Fundus photo; 45-degree field of view
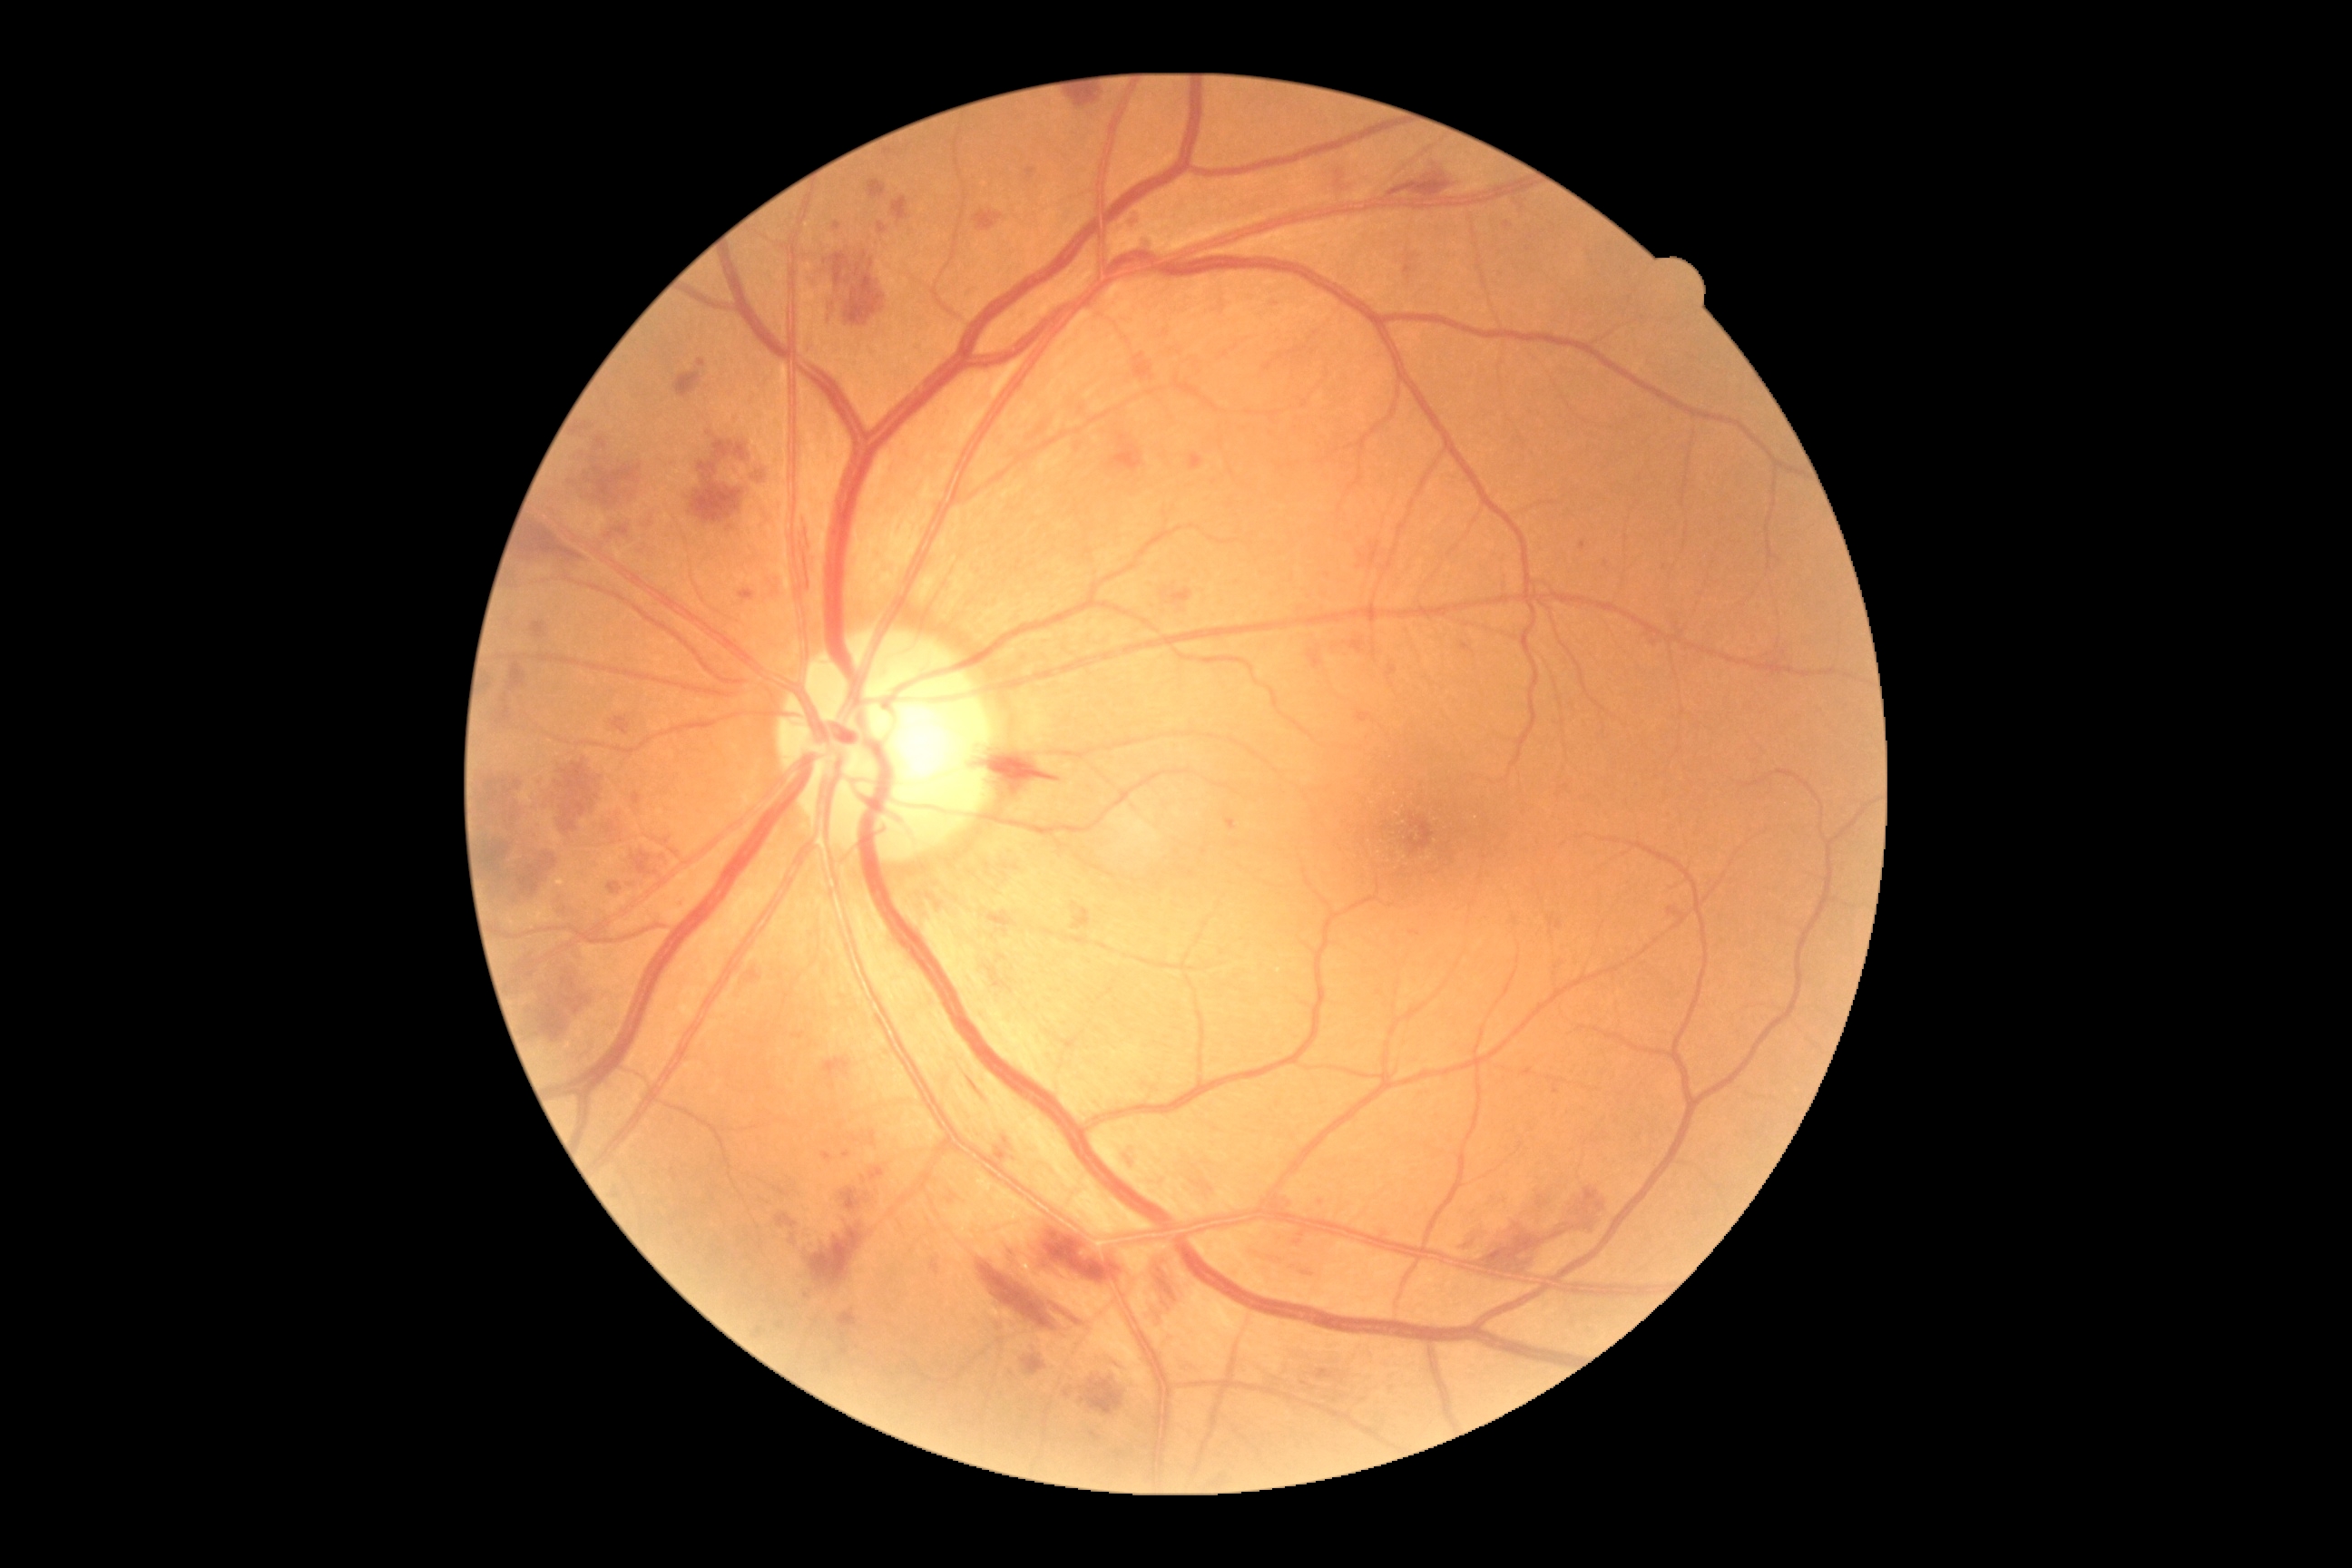 partial: true
dr_grade: 3
lesions:
  ma:
    - bbox(794, 1034, 803, 1041)
    - bbox(1293, 1240, 1302, 1246)
    - bbox(596, 436, 607, 449)
    - bbox(738, 589, 754, 602)
    - bbox(968, 291, 975, 300)
    - bbox(1112, 1364, 1124, 1371)
    - bbox(632, 792, 642, 805)
    - bbox(1547, 917, 1554, 928)
    - bbox(531, 622, 545, 640)
    - bbox(930, 1257, 939, 1275)
    - bbox(1411, 932, 1420, 936)
    - bbox(1115, 1451, 1124, 1460)
    - bbox(1580, 542, 1587, 551)
    - bbox(1387, 665, 1398, 678)
  ma_small_approx:
    - [x=1075, y=907]
    - [x=864, y=1179]
    - [x=681, y=906]
    - [x=794, y=1238]
  he:
    - bbox(487, 847, 509, 863)
    - bbox(965, 1073, 990, 1104)
    - bbox(741, 959, 767, 985)
    - bbox(511, 663, 527, 691)
    - bbox(603, 810, 629, 834)
    - bbox(1308, 651, 1324, 671)
    - bbox(611, 716, 631, 736)
    - bbox(1112, 435, 1142, 473)
    - bbox(1667, 908, 1687, 923)
    - bbox(1141, 1257, 1184, 1326)
    - bbox(1482, 1304, 1525, 1351)
    - bbox(870, 1168, 887, 1182)
    - bbox(1055, 1308, 1083, 1328)
    - bbox(536, 968, 593, 1043)
    - bbox(534, 758, 609, 832)